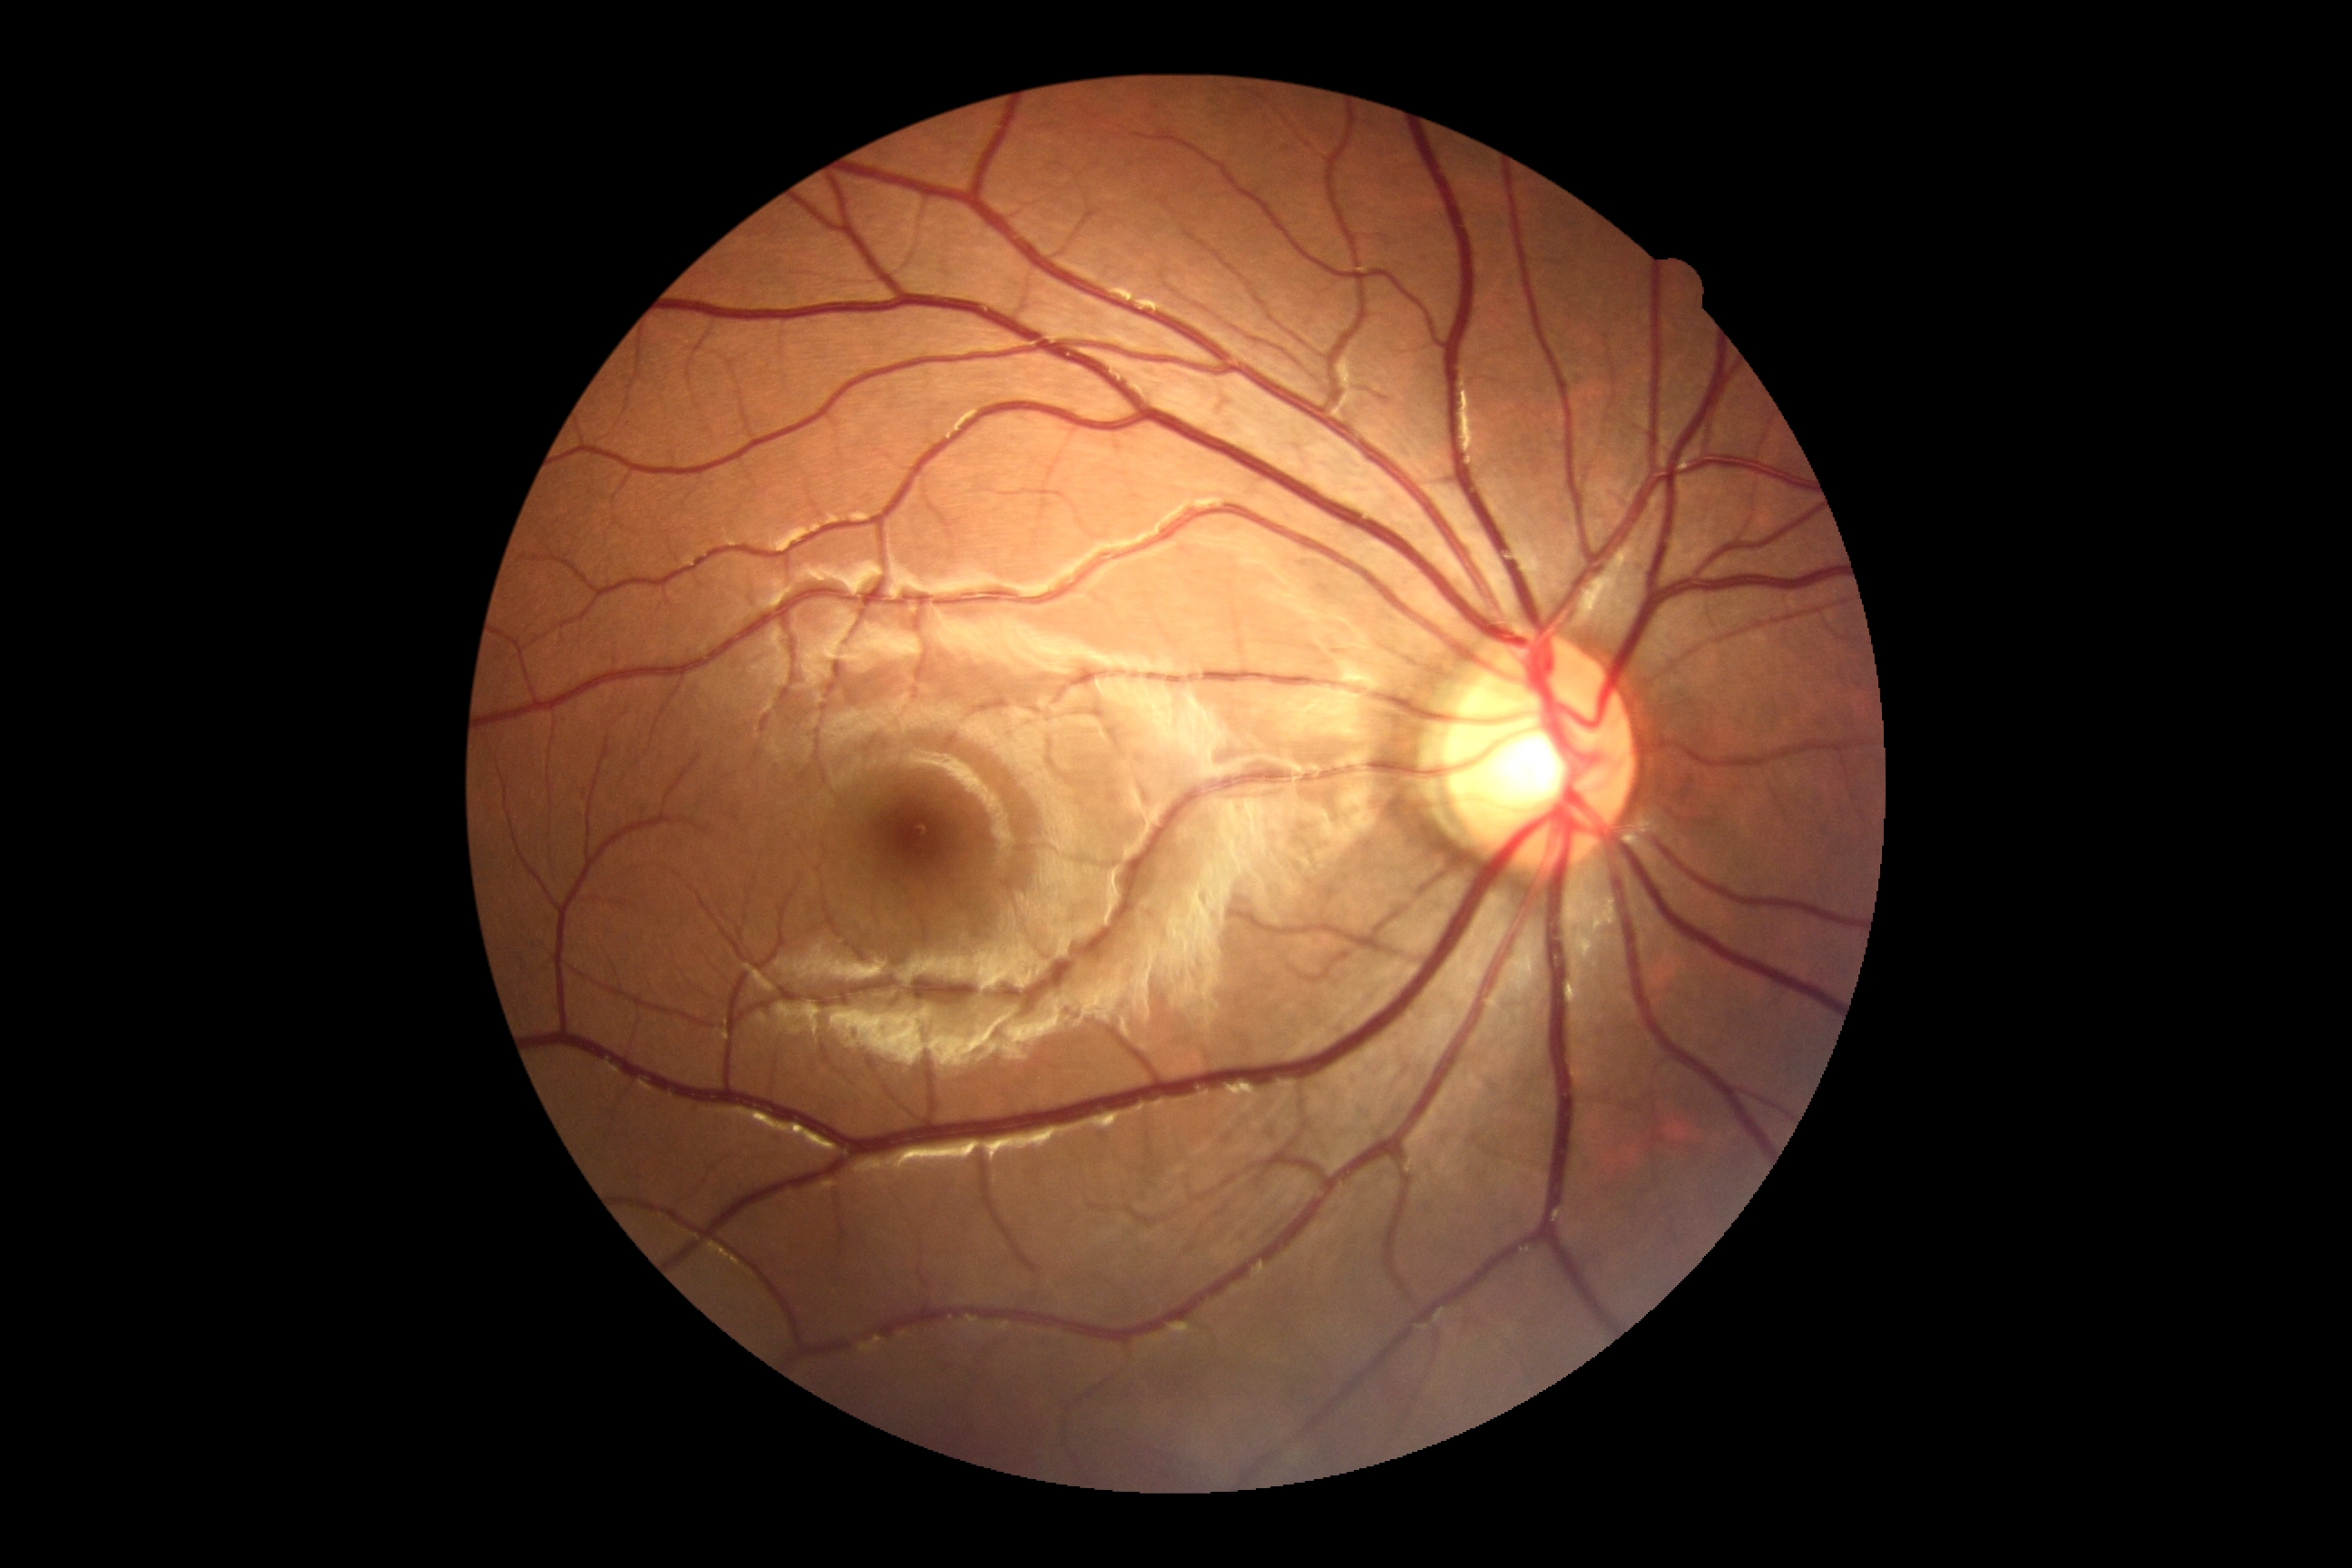
Findings:
- DR stage: 0
- DR impression: no apparent DR